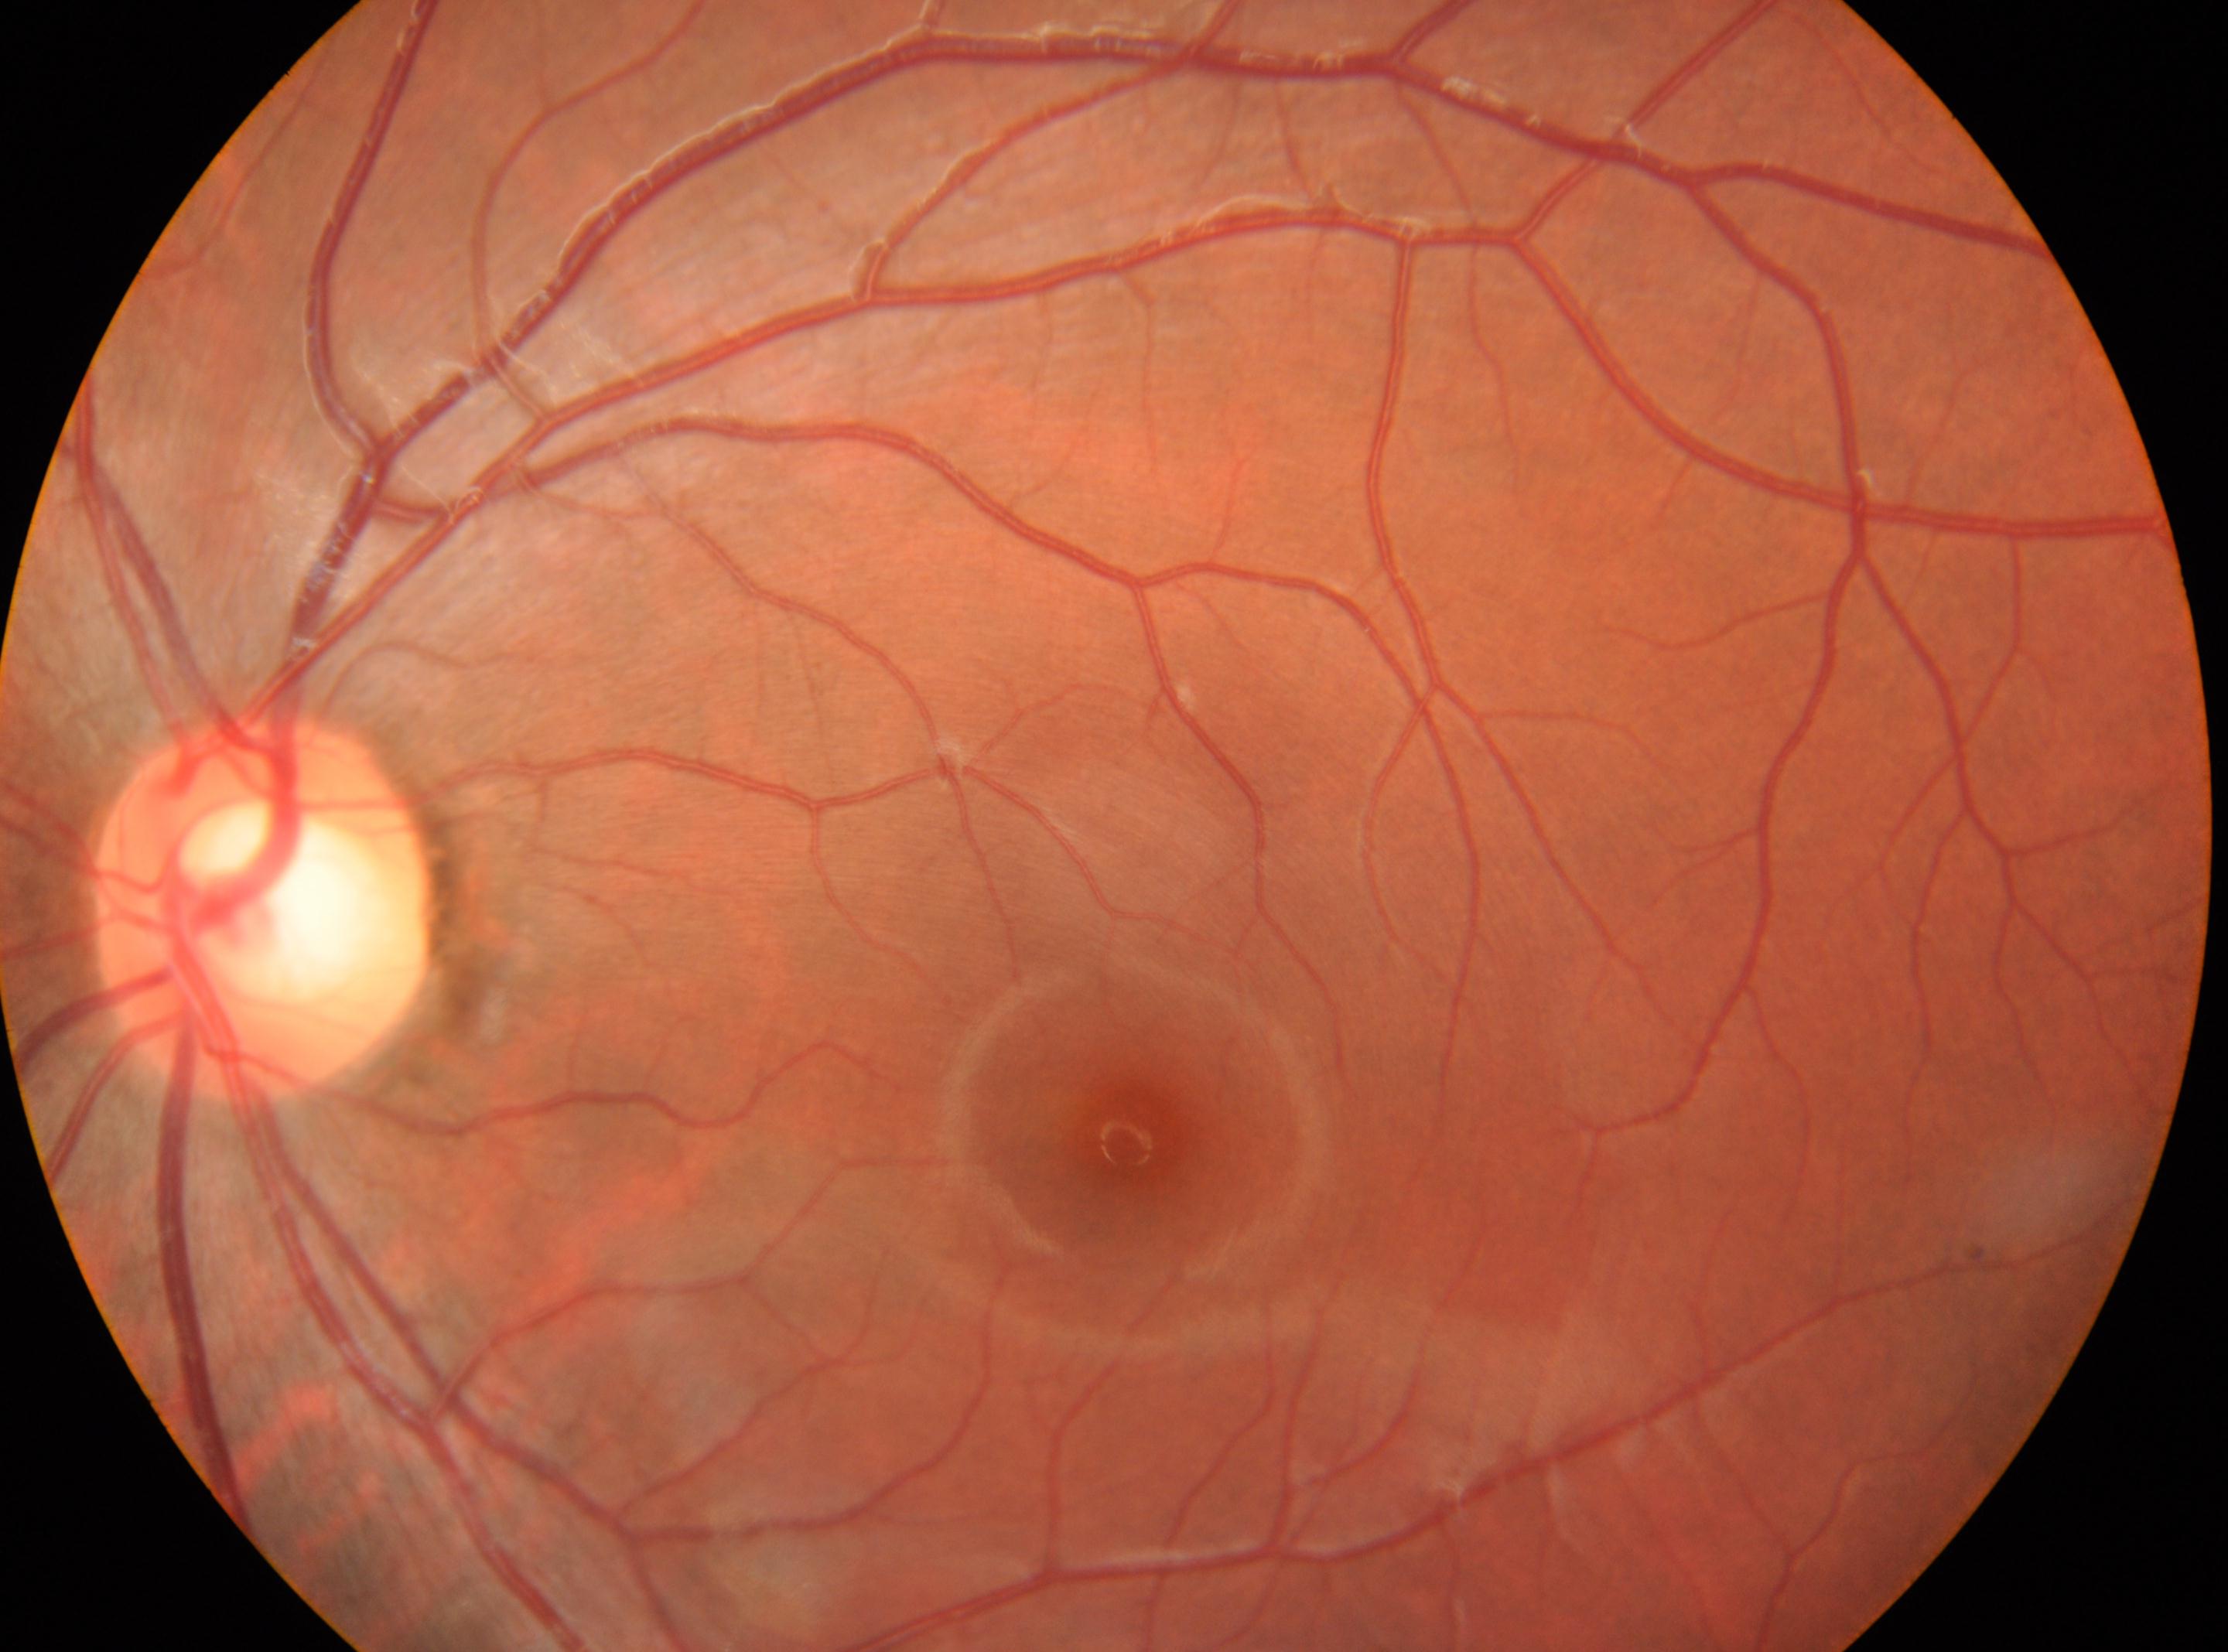 Findings:
– macula center — (1134, 1135)
– laterality — left
– disc center — (265, 911)
– DR stage — 0/4